CFP.
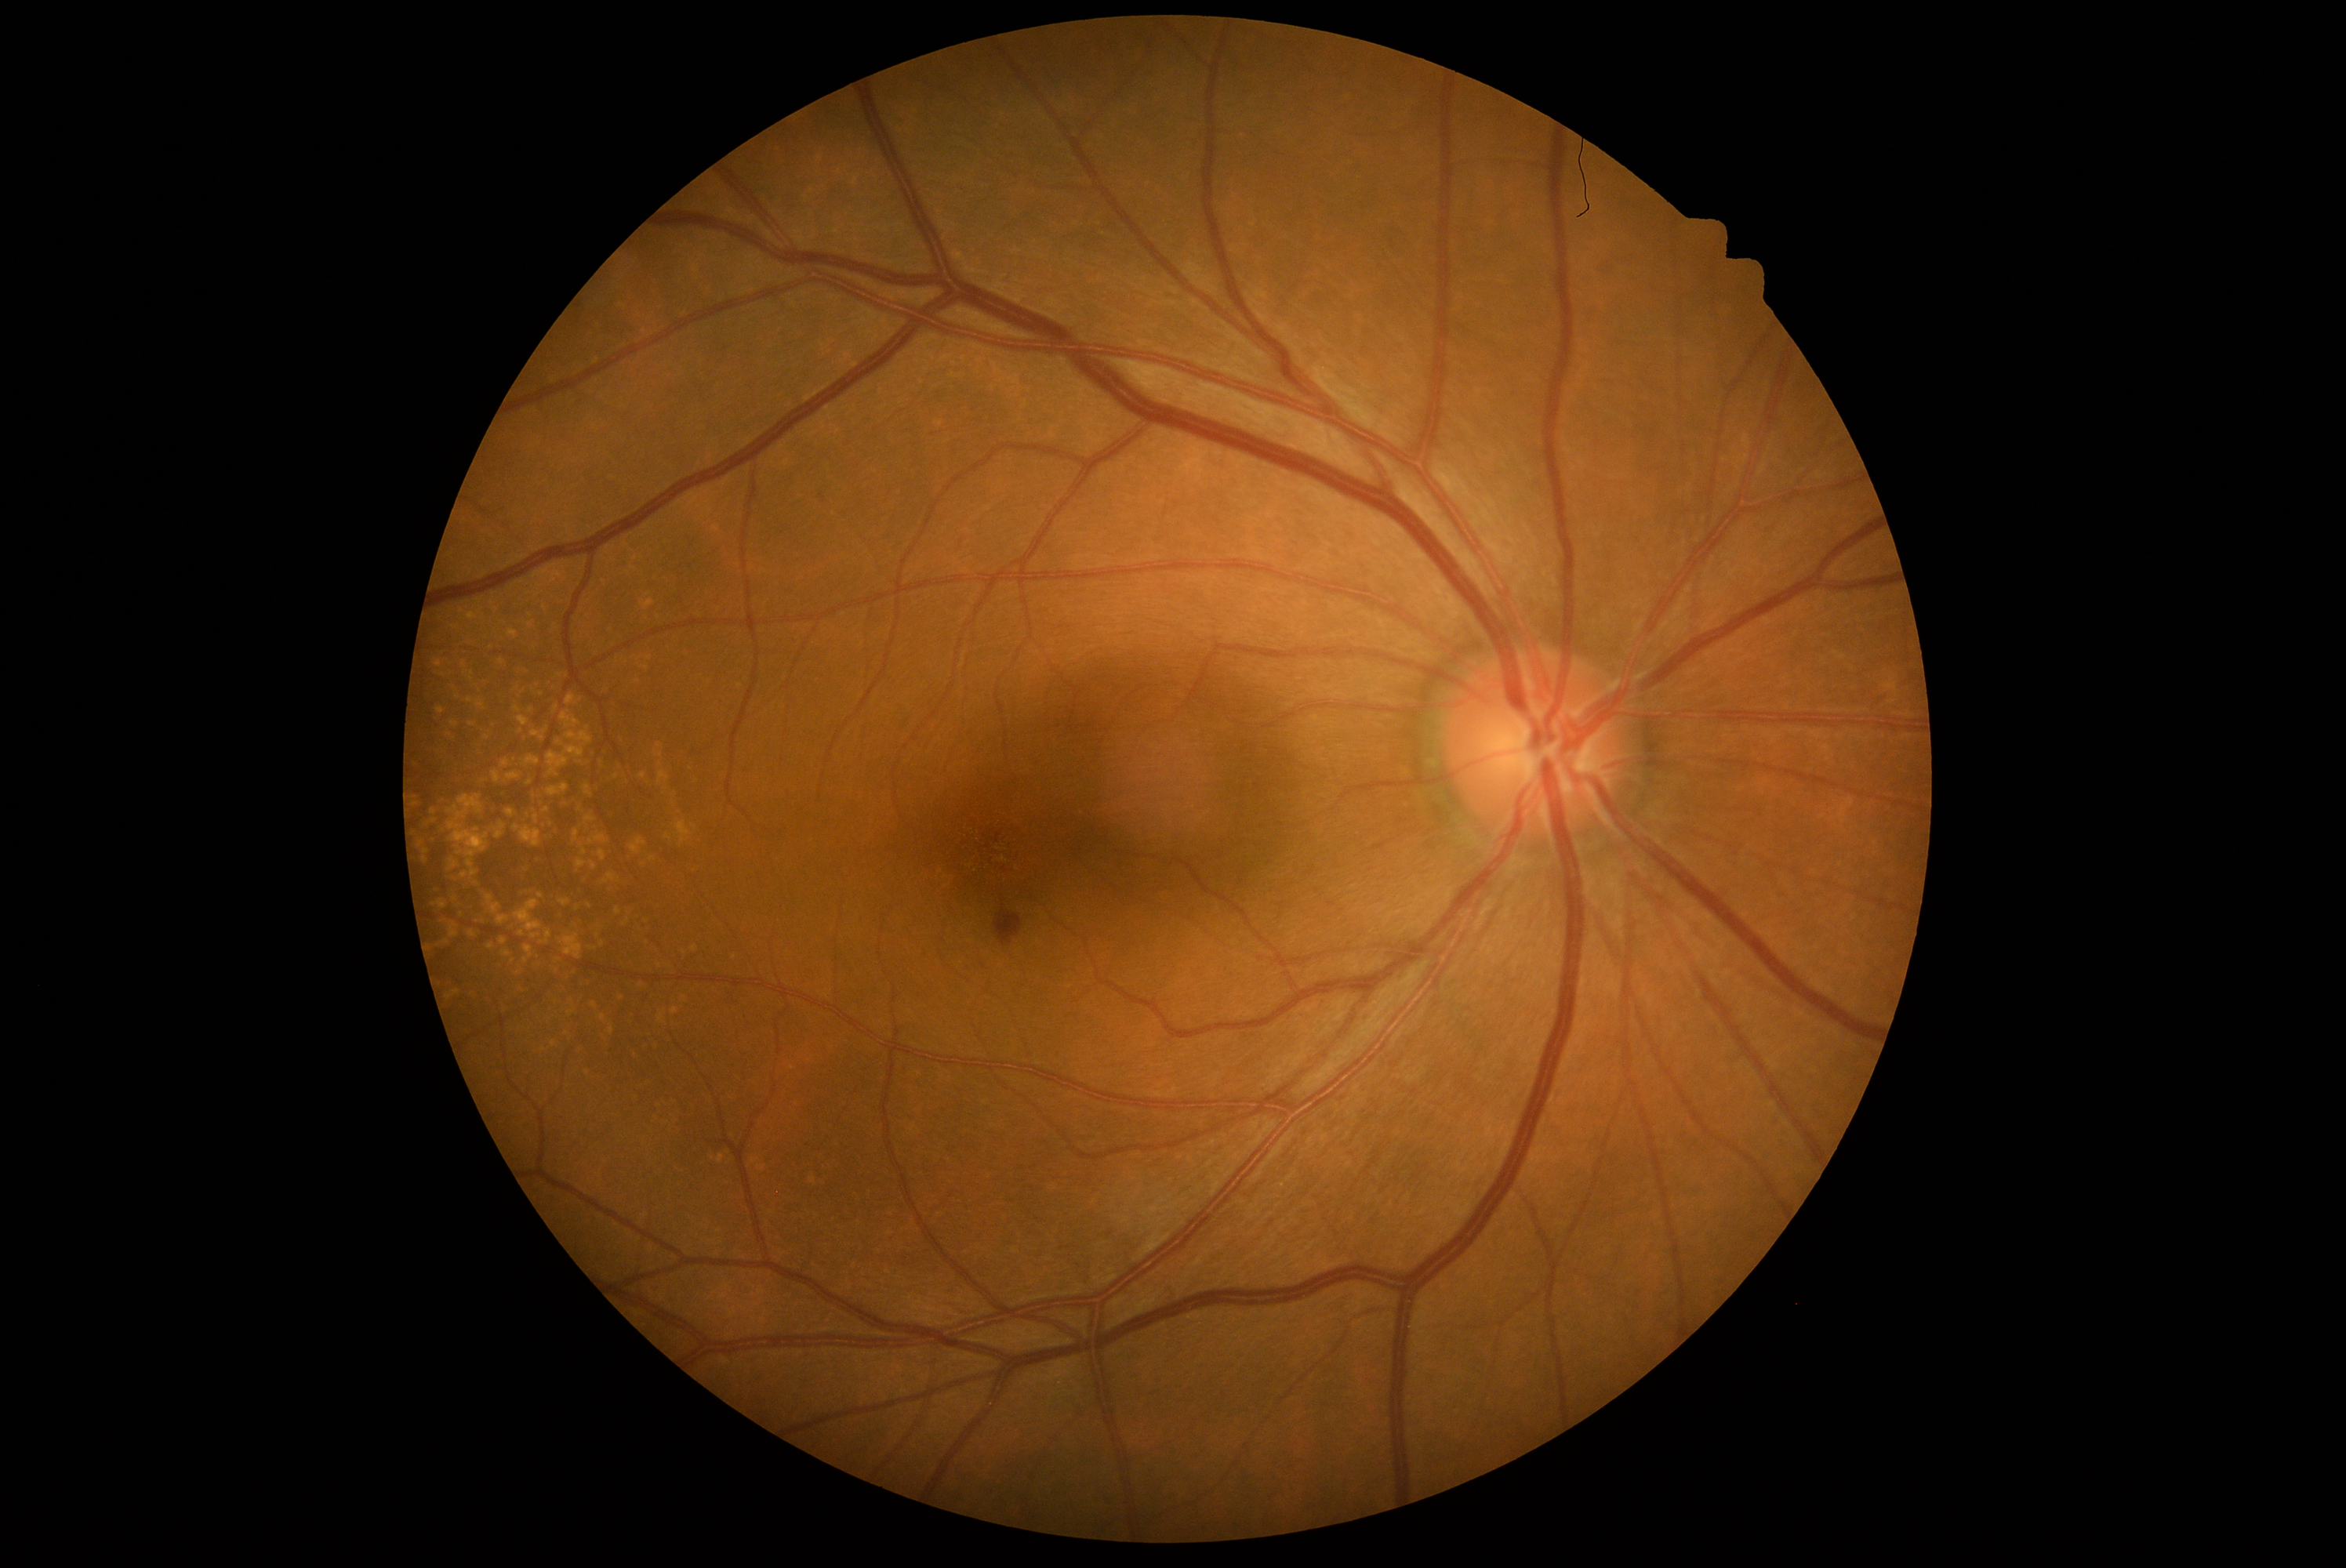

Diabetic retinopathy is grade 2 (moderate NPDR)
hemorrhages: {"left": 995, "top": 899, "right": 1023, "bottom": 945}
hard exudates: not present
soft exudates: not present
microaneurysms: not present